Wide-field fundus photograph from neonatal ROP screening. 640 by 480 pixels — 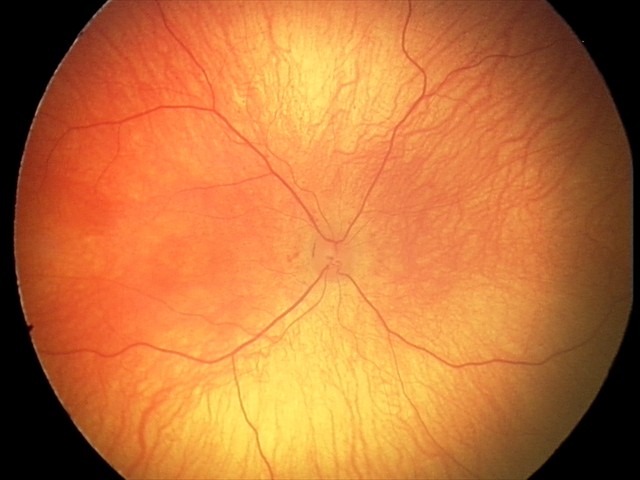 Q: What is the diagnosis from this examination?
A: physiological retinal finding